FOV: 45 degrees, NIDEK AFC-230 fundus camera: 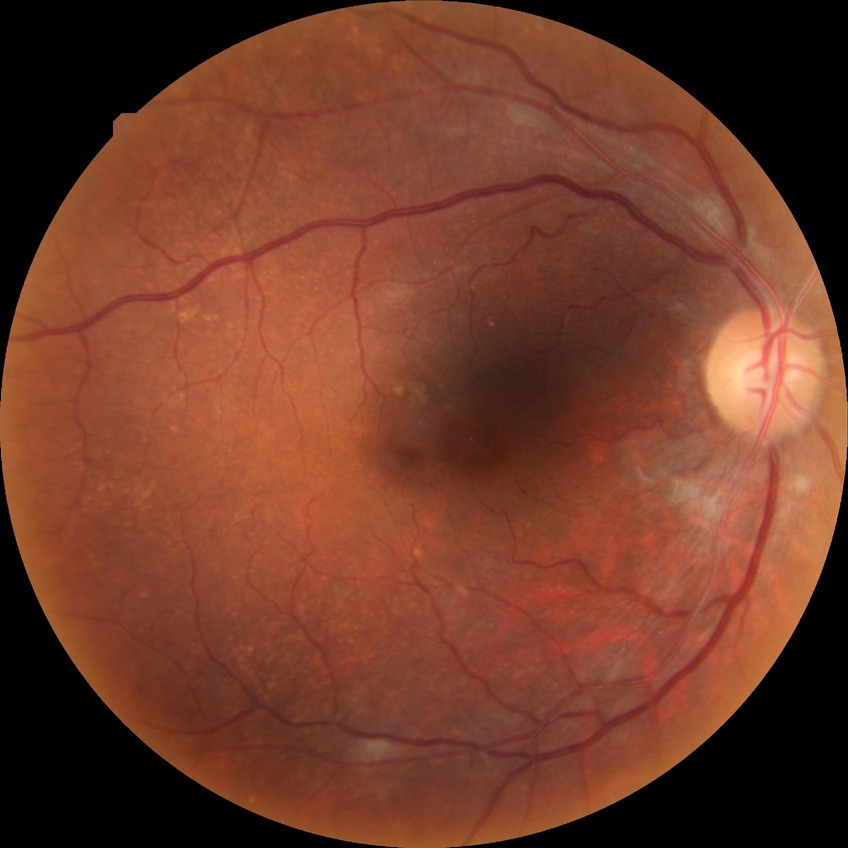
Diabetic retinopathy (DR) is no diabetic retinopathy (NDR).